45-degree field of view, CFP, 1380x1382px
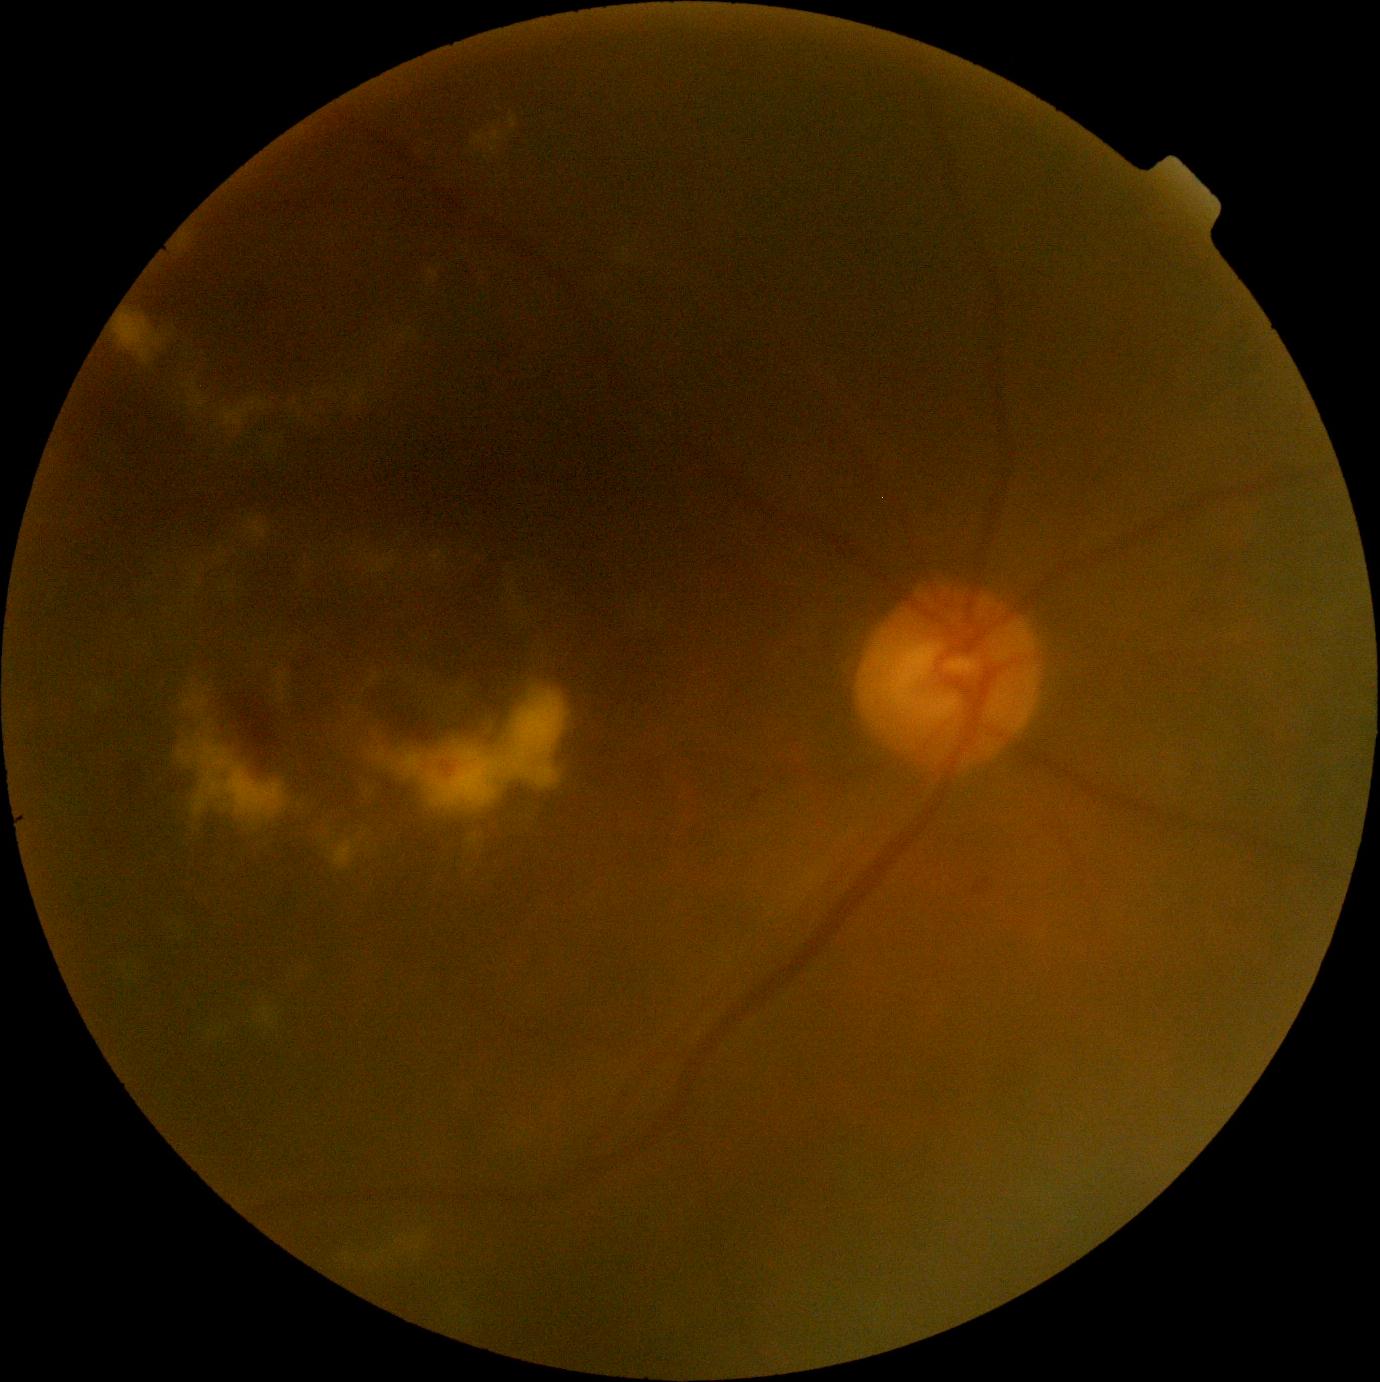

Annotations:
* DR stage: 2